Wide-field fundus image from infant ROP screening.
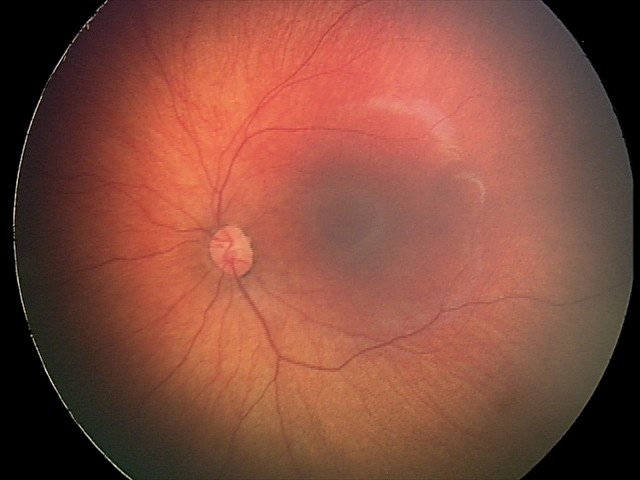
Diagnosis from this screening exam: retinal hemorrhages.